Color fundus photograph; image size 2352x1568.
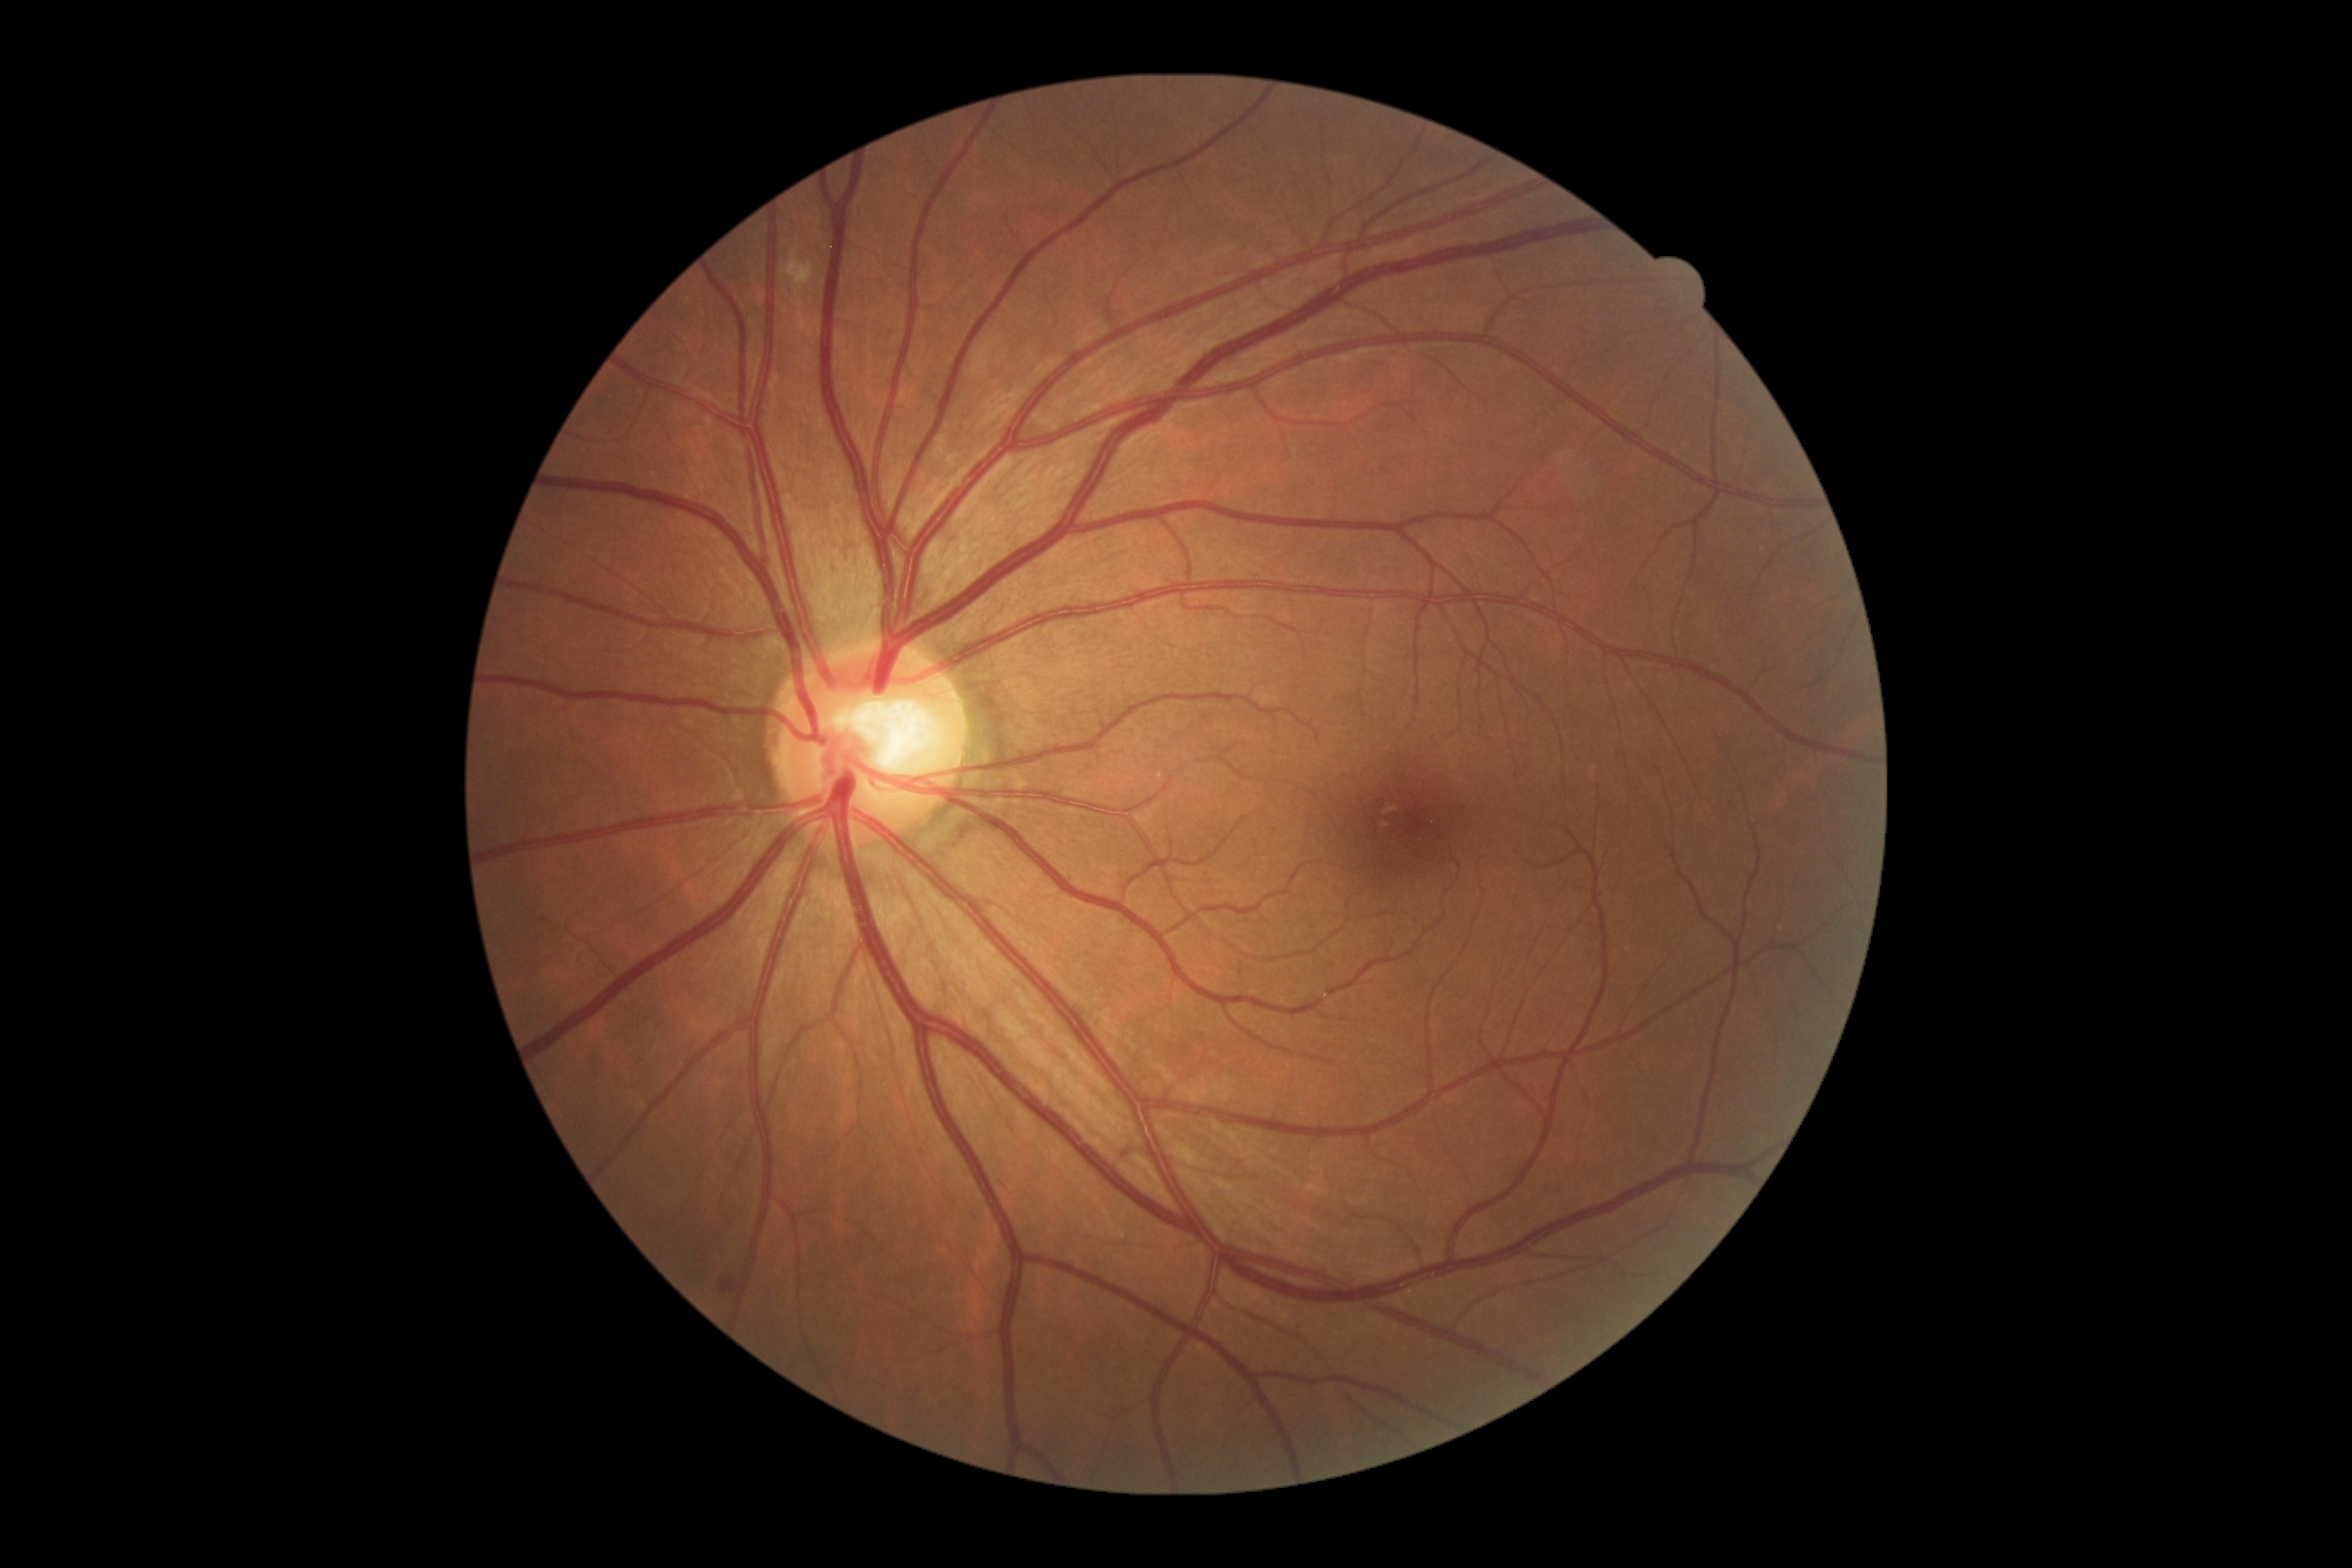
The retinopathy is classified as non-proliferative diabetic retinopathy. DR stage: 2.